Pediatric wide-field fundus photograph; acquired on the Phoenix ICON: 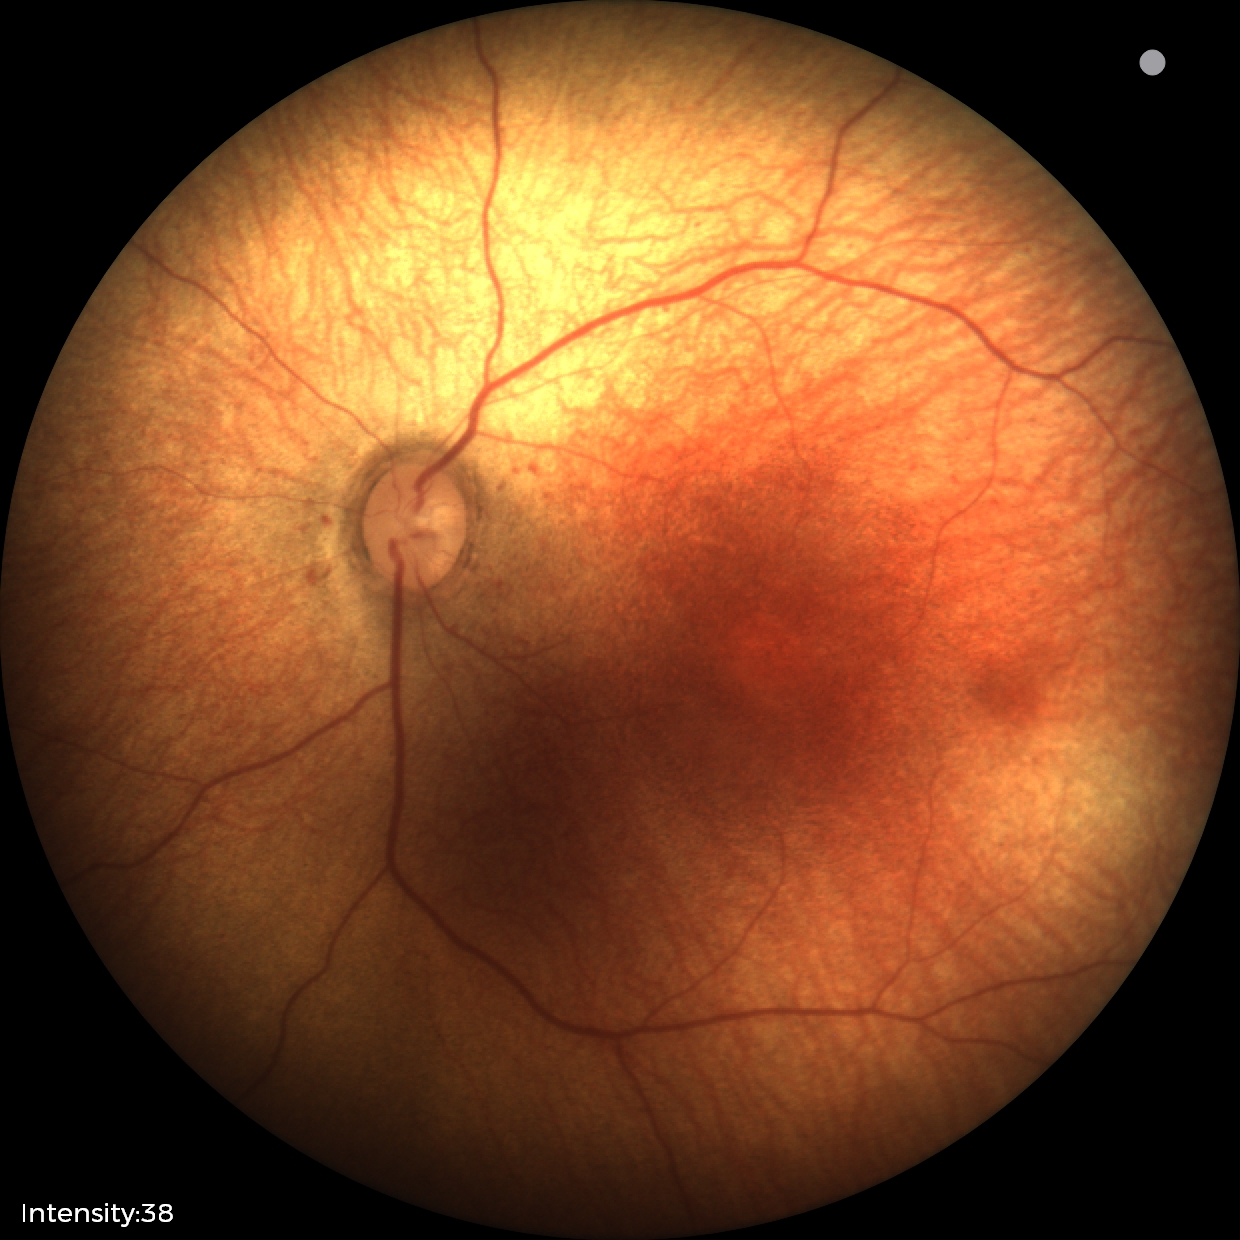

Screening: physiological retinal finding.